Posterior pole color fundus photograph
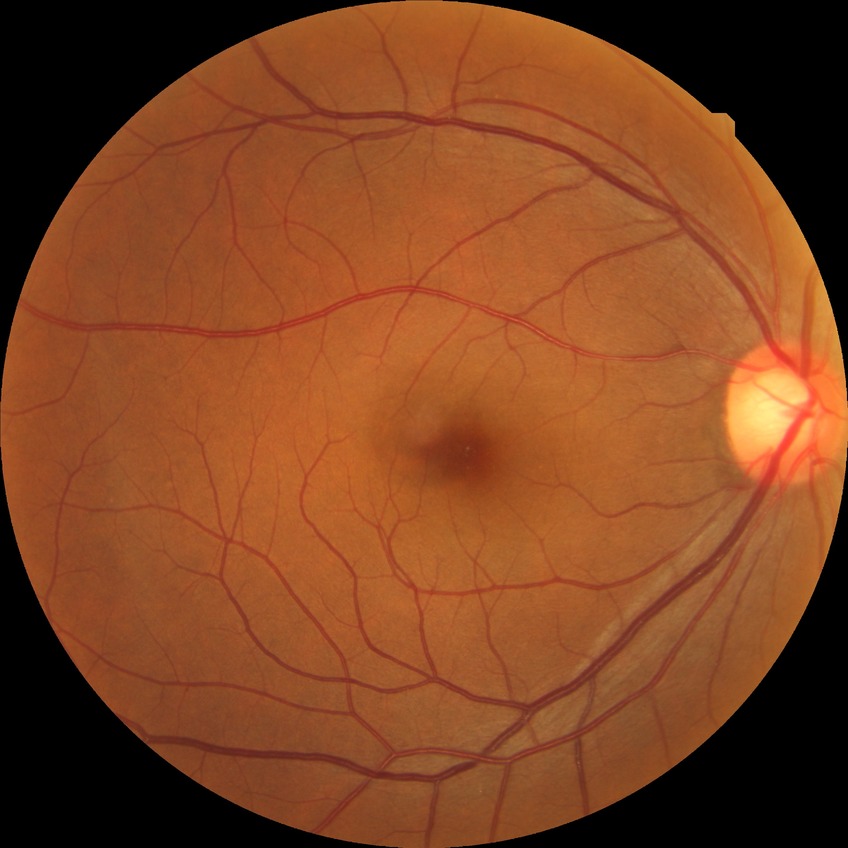

Diabetic retinopathy (DR): NDR (no diabetic retinopathy).